2228x1652 · fundus photo · camera: Topcon TRC-50DX.
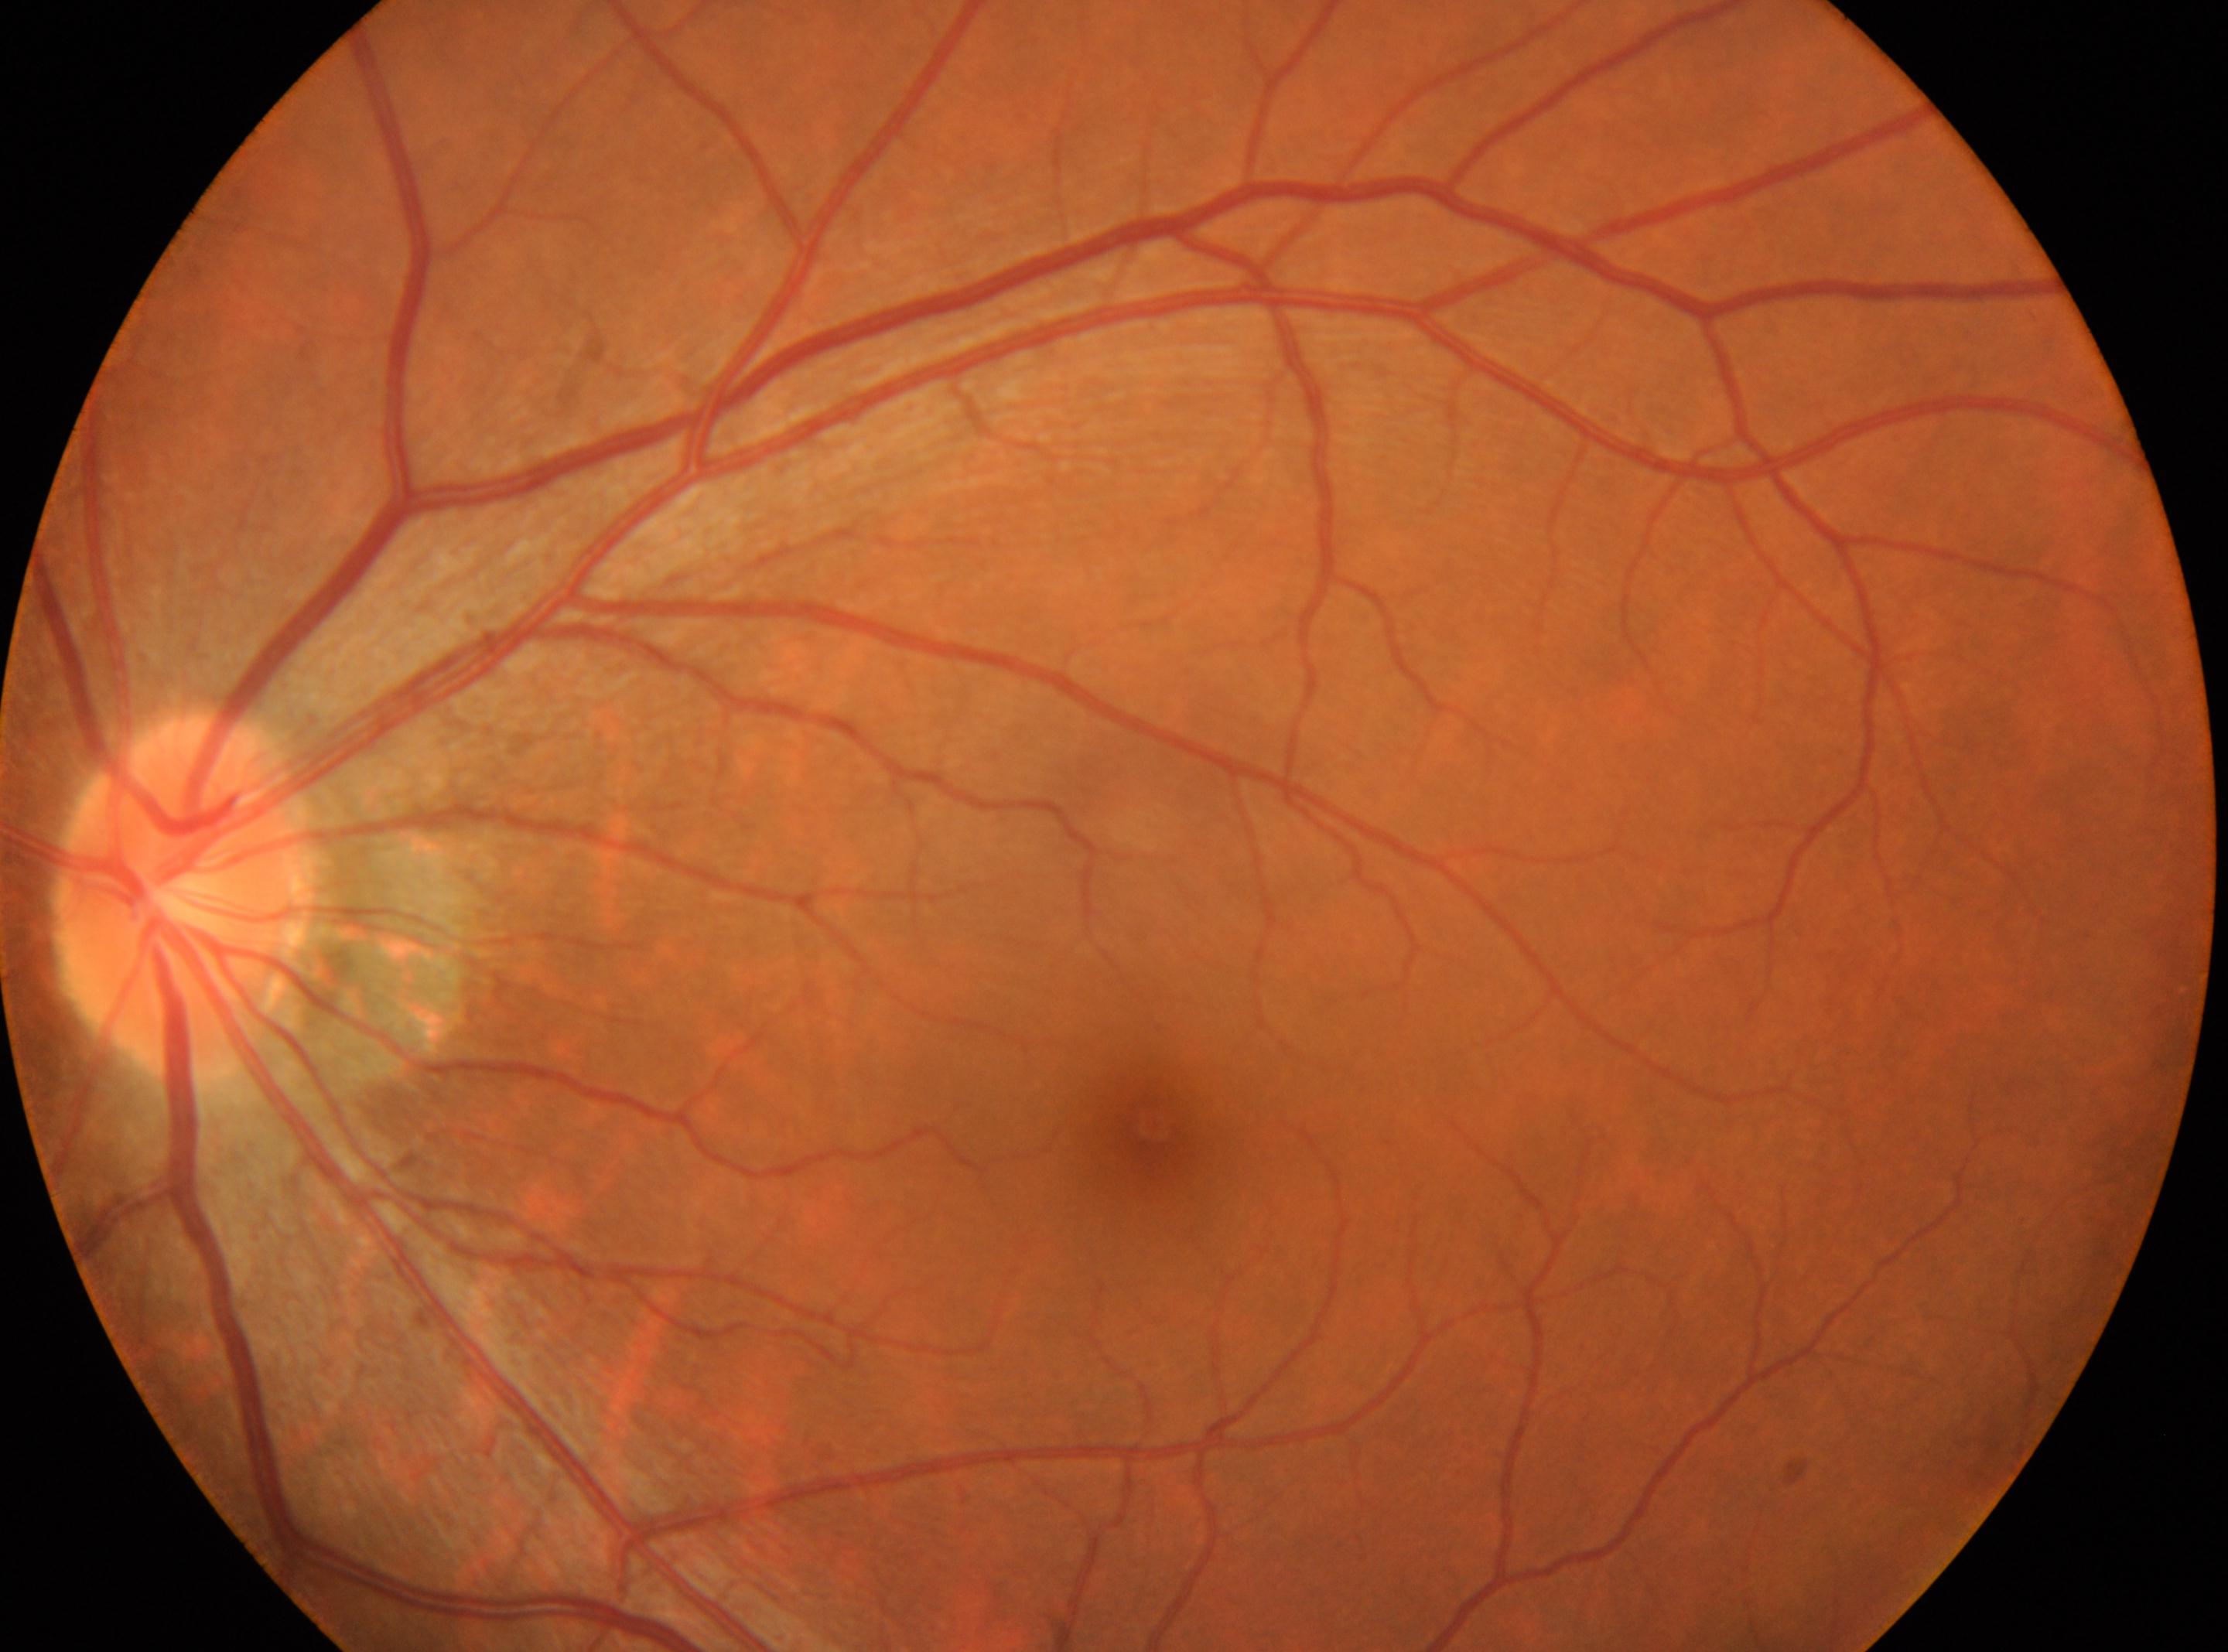

Eye: left. DR: 0. The disc center is at [179, 896]. The foveal center is at [1151, 1126]. No apparent diabetic retinopathy.